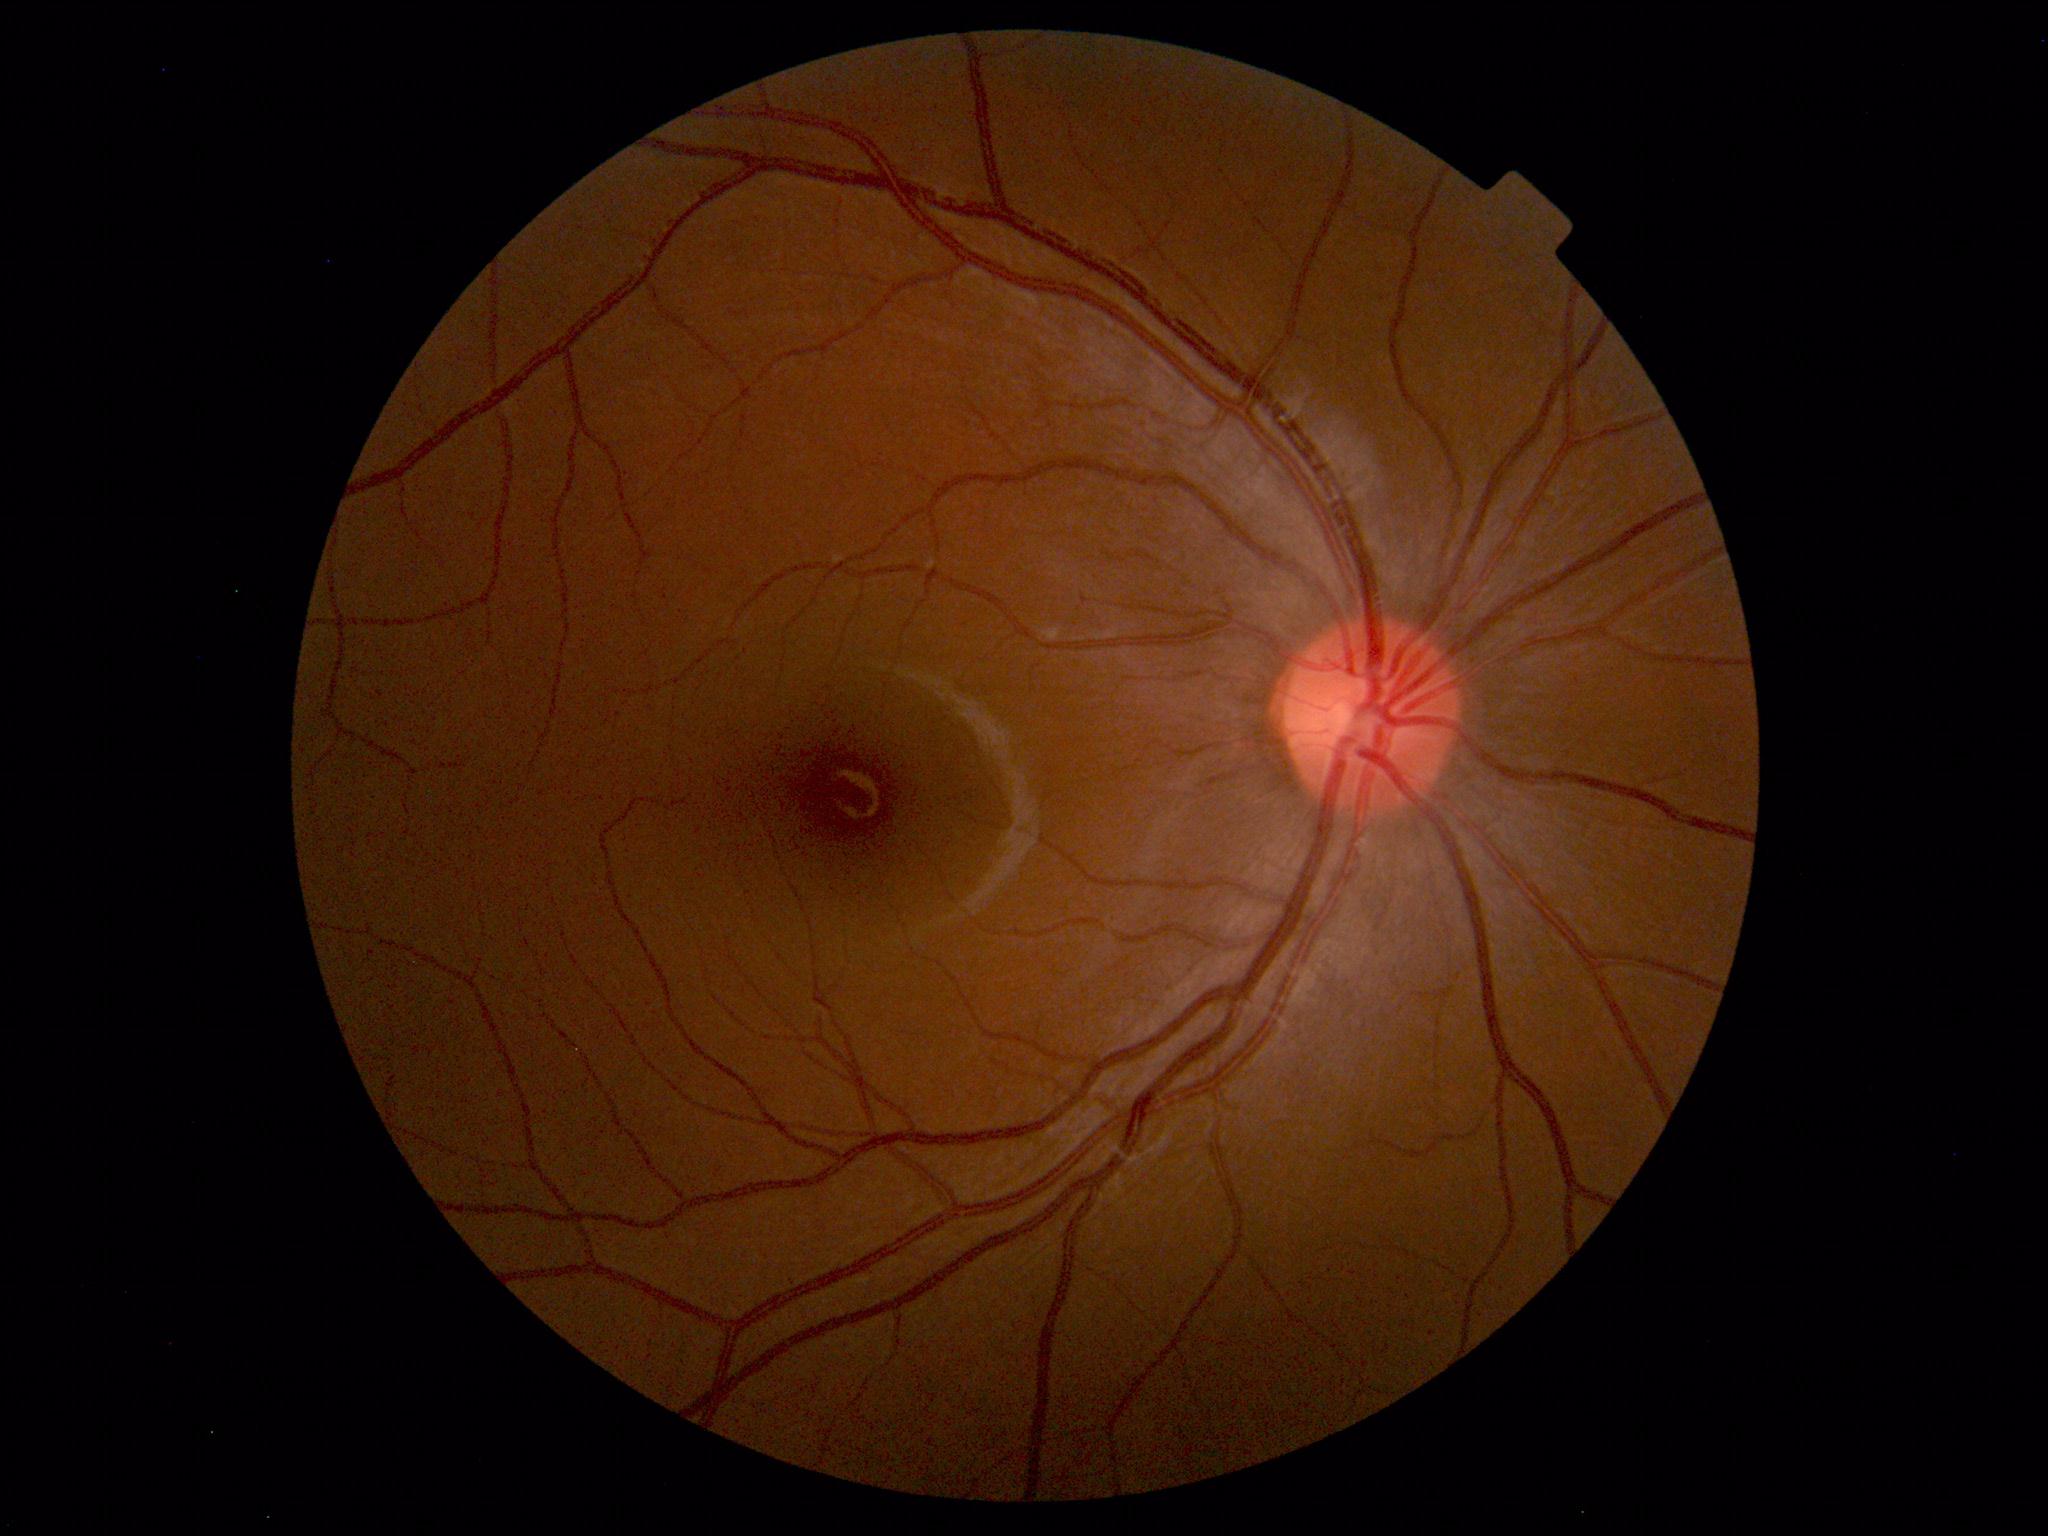 Diagnosis: normal.